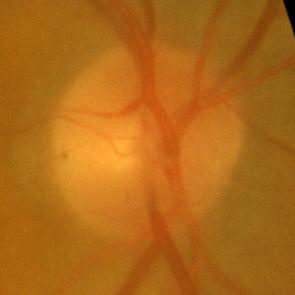
Glaucoma assessment = no glaucomatous changes.